Camera: NIDEK AFC-230.
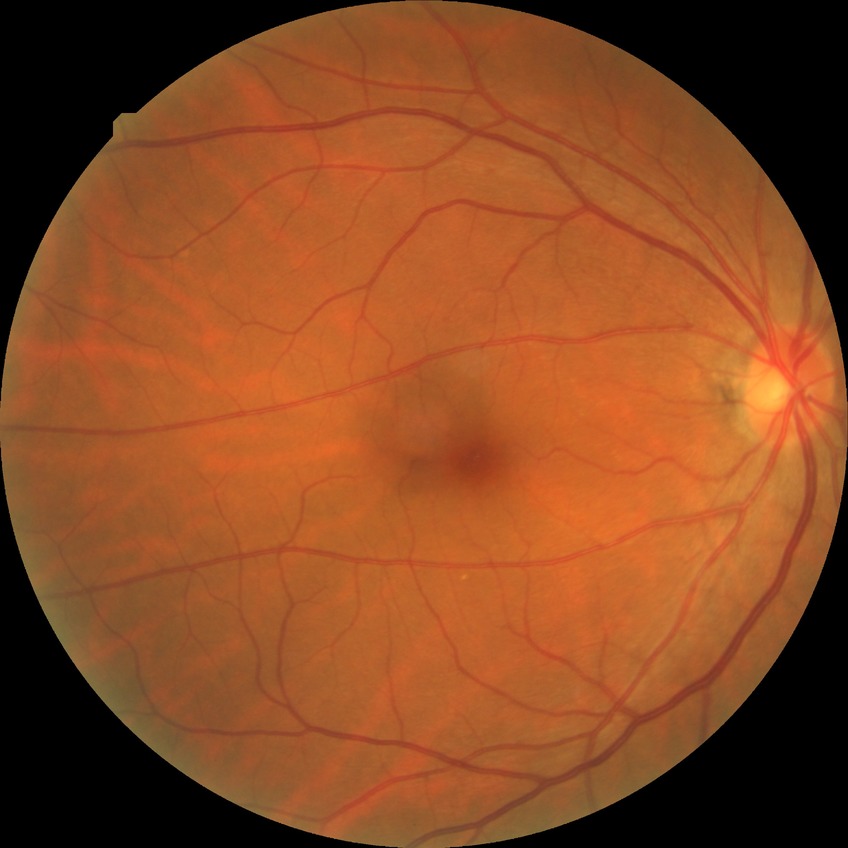 Diabetic retinopathy (DR): NDR (no diabetic retinopathy).